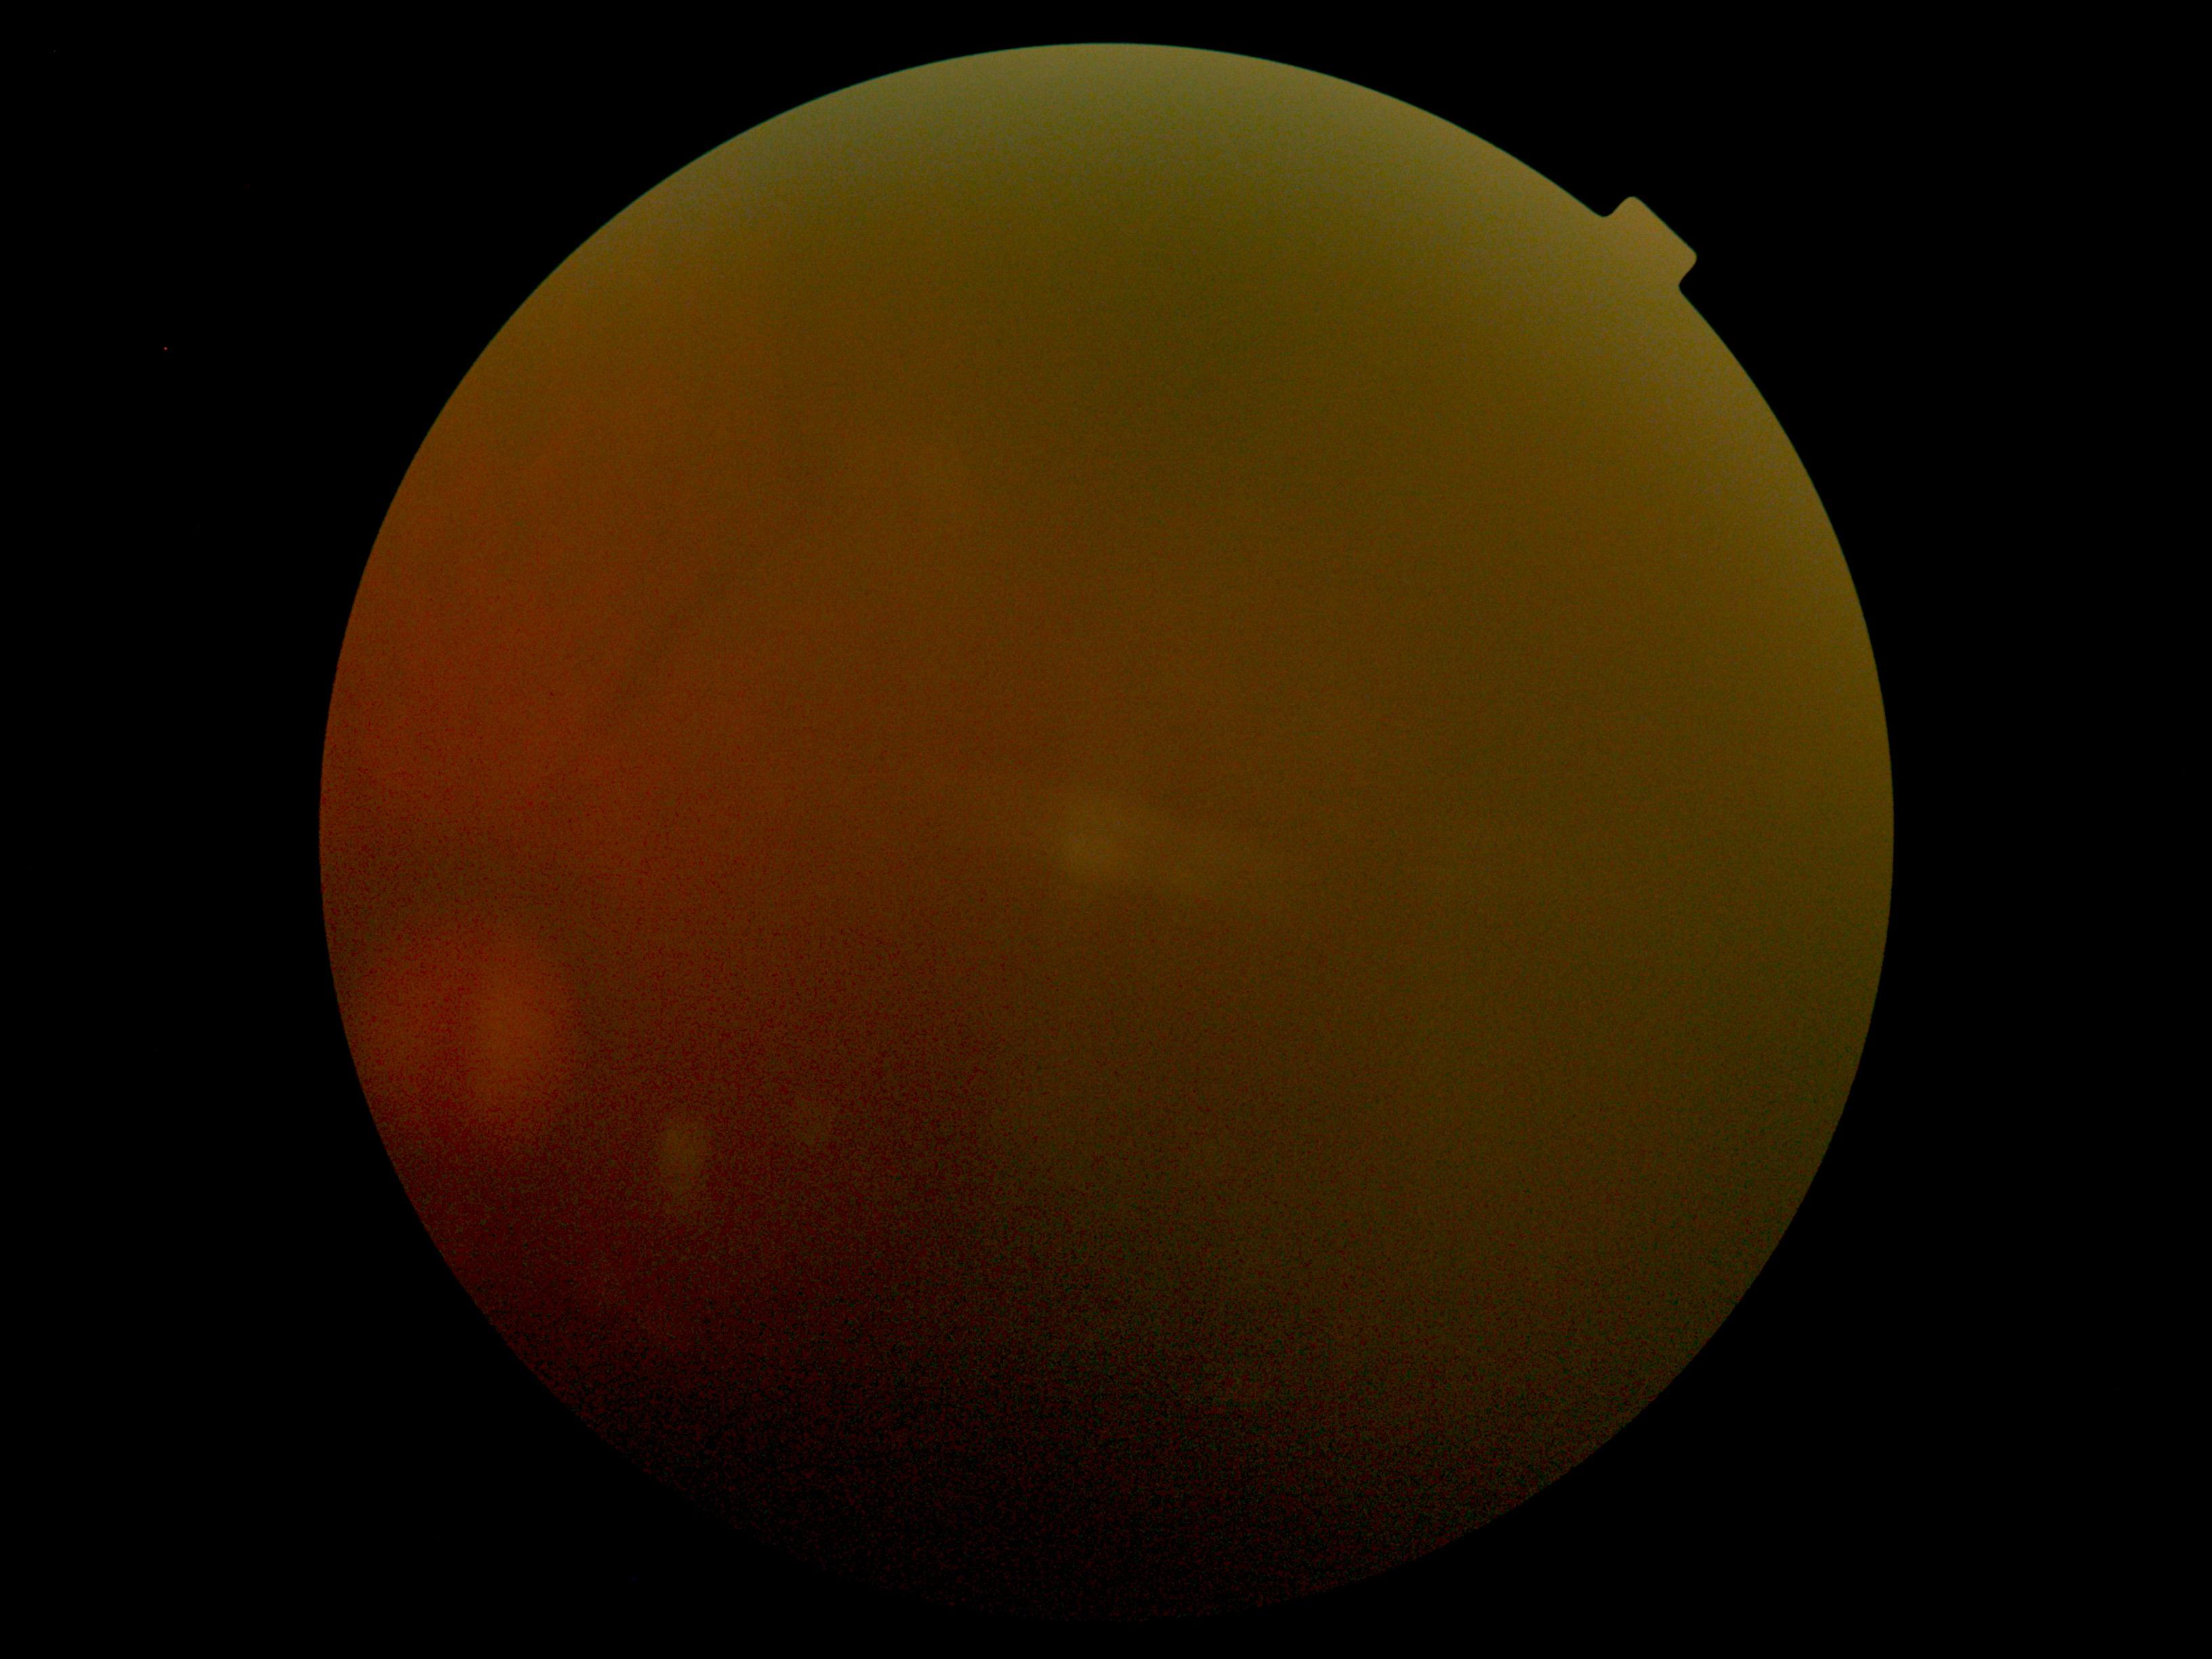

Diabetic retinopathy: ungradable.
Ungradable image — DR severity cannot be determined.